848 by 848 pixels, 45 degree fundus photograph, camera: NIDEK AFC-230, color fundus image: 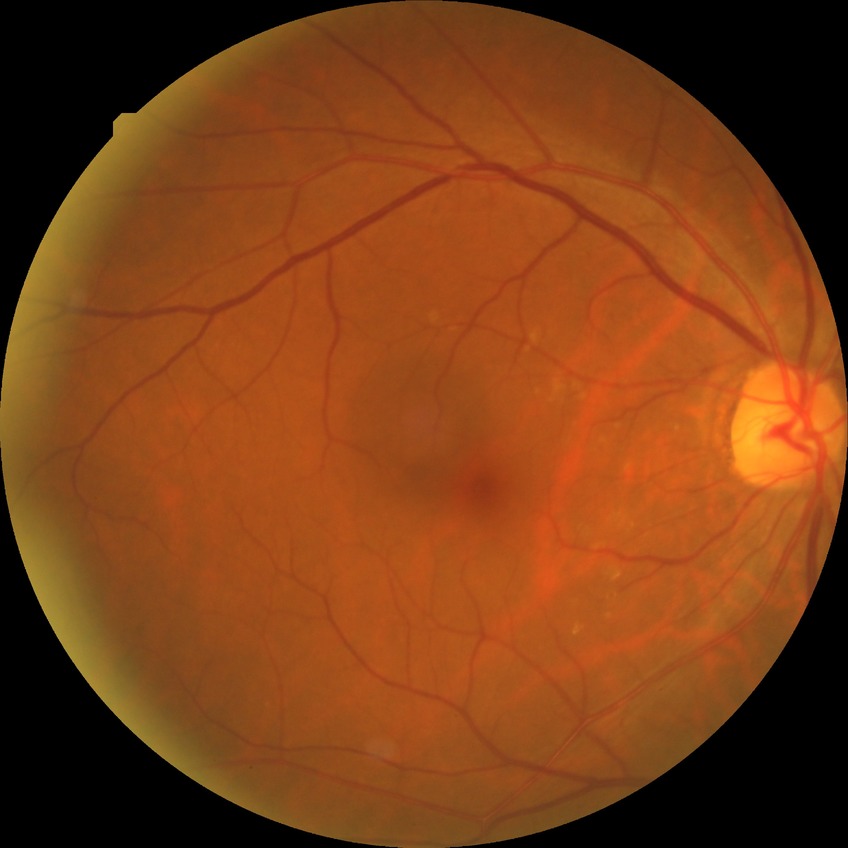 Modified Davis classification is no diabetic retinopathy.